848 by 848 pixels; color fundus photograph: 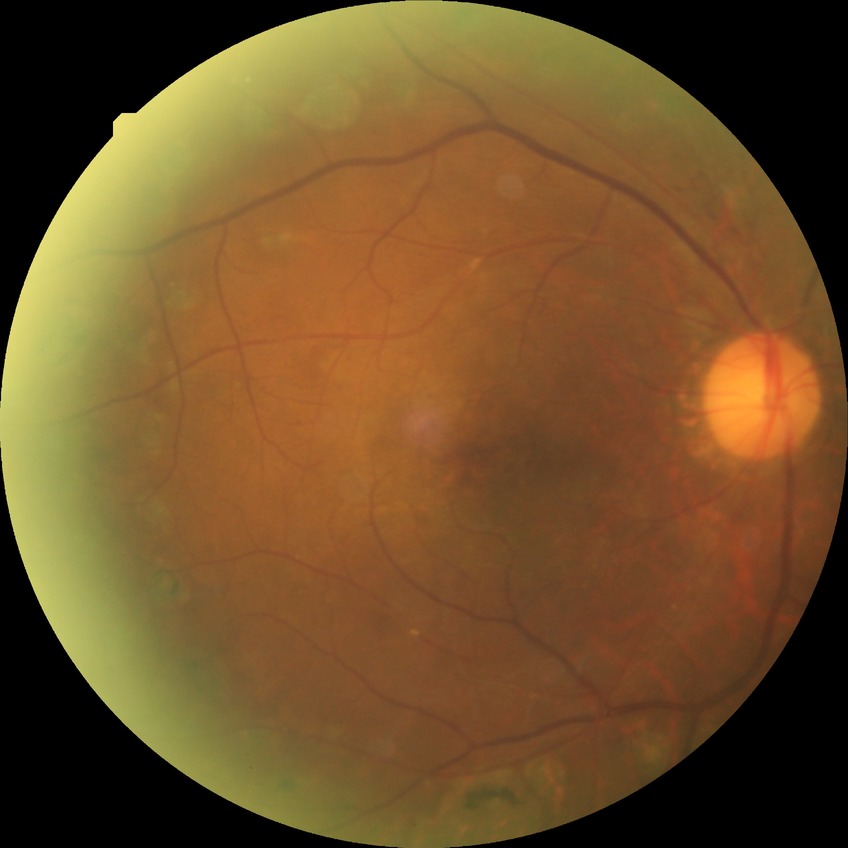

Retinopathy stage is proliferative diabetic retinopathy.